Centered on the macula:
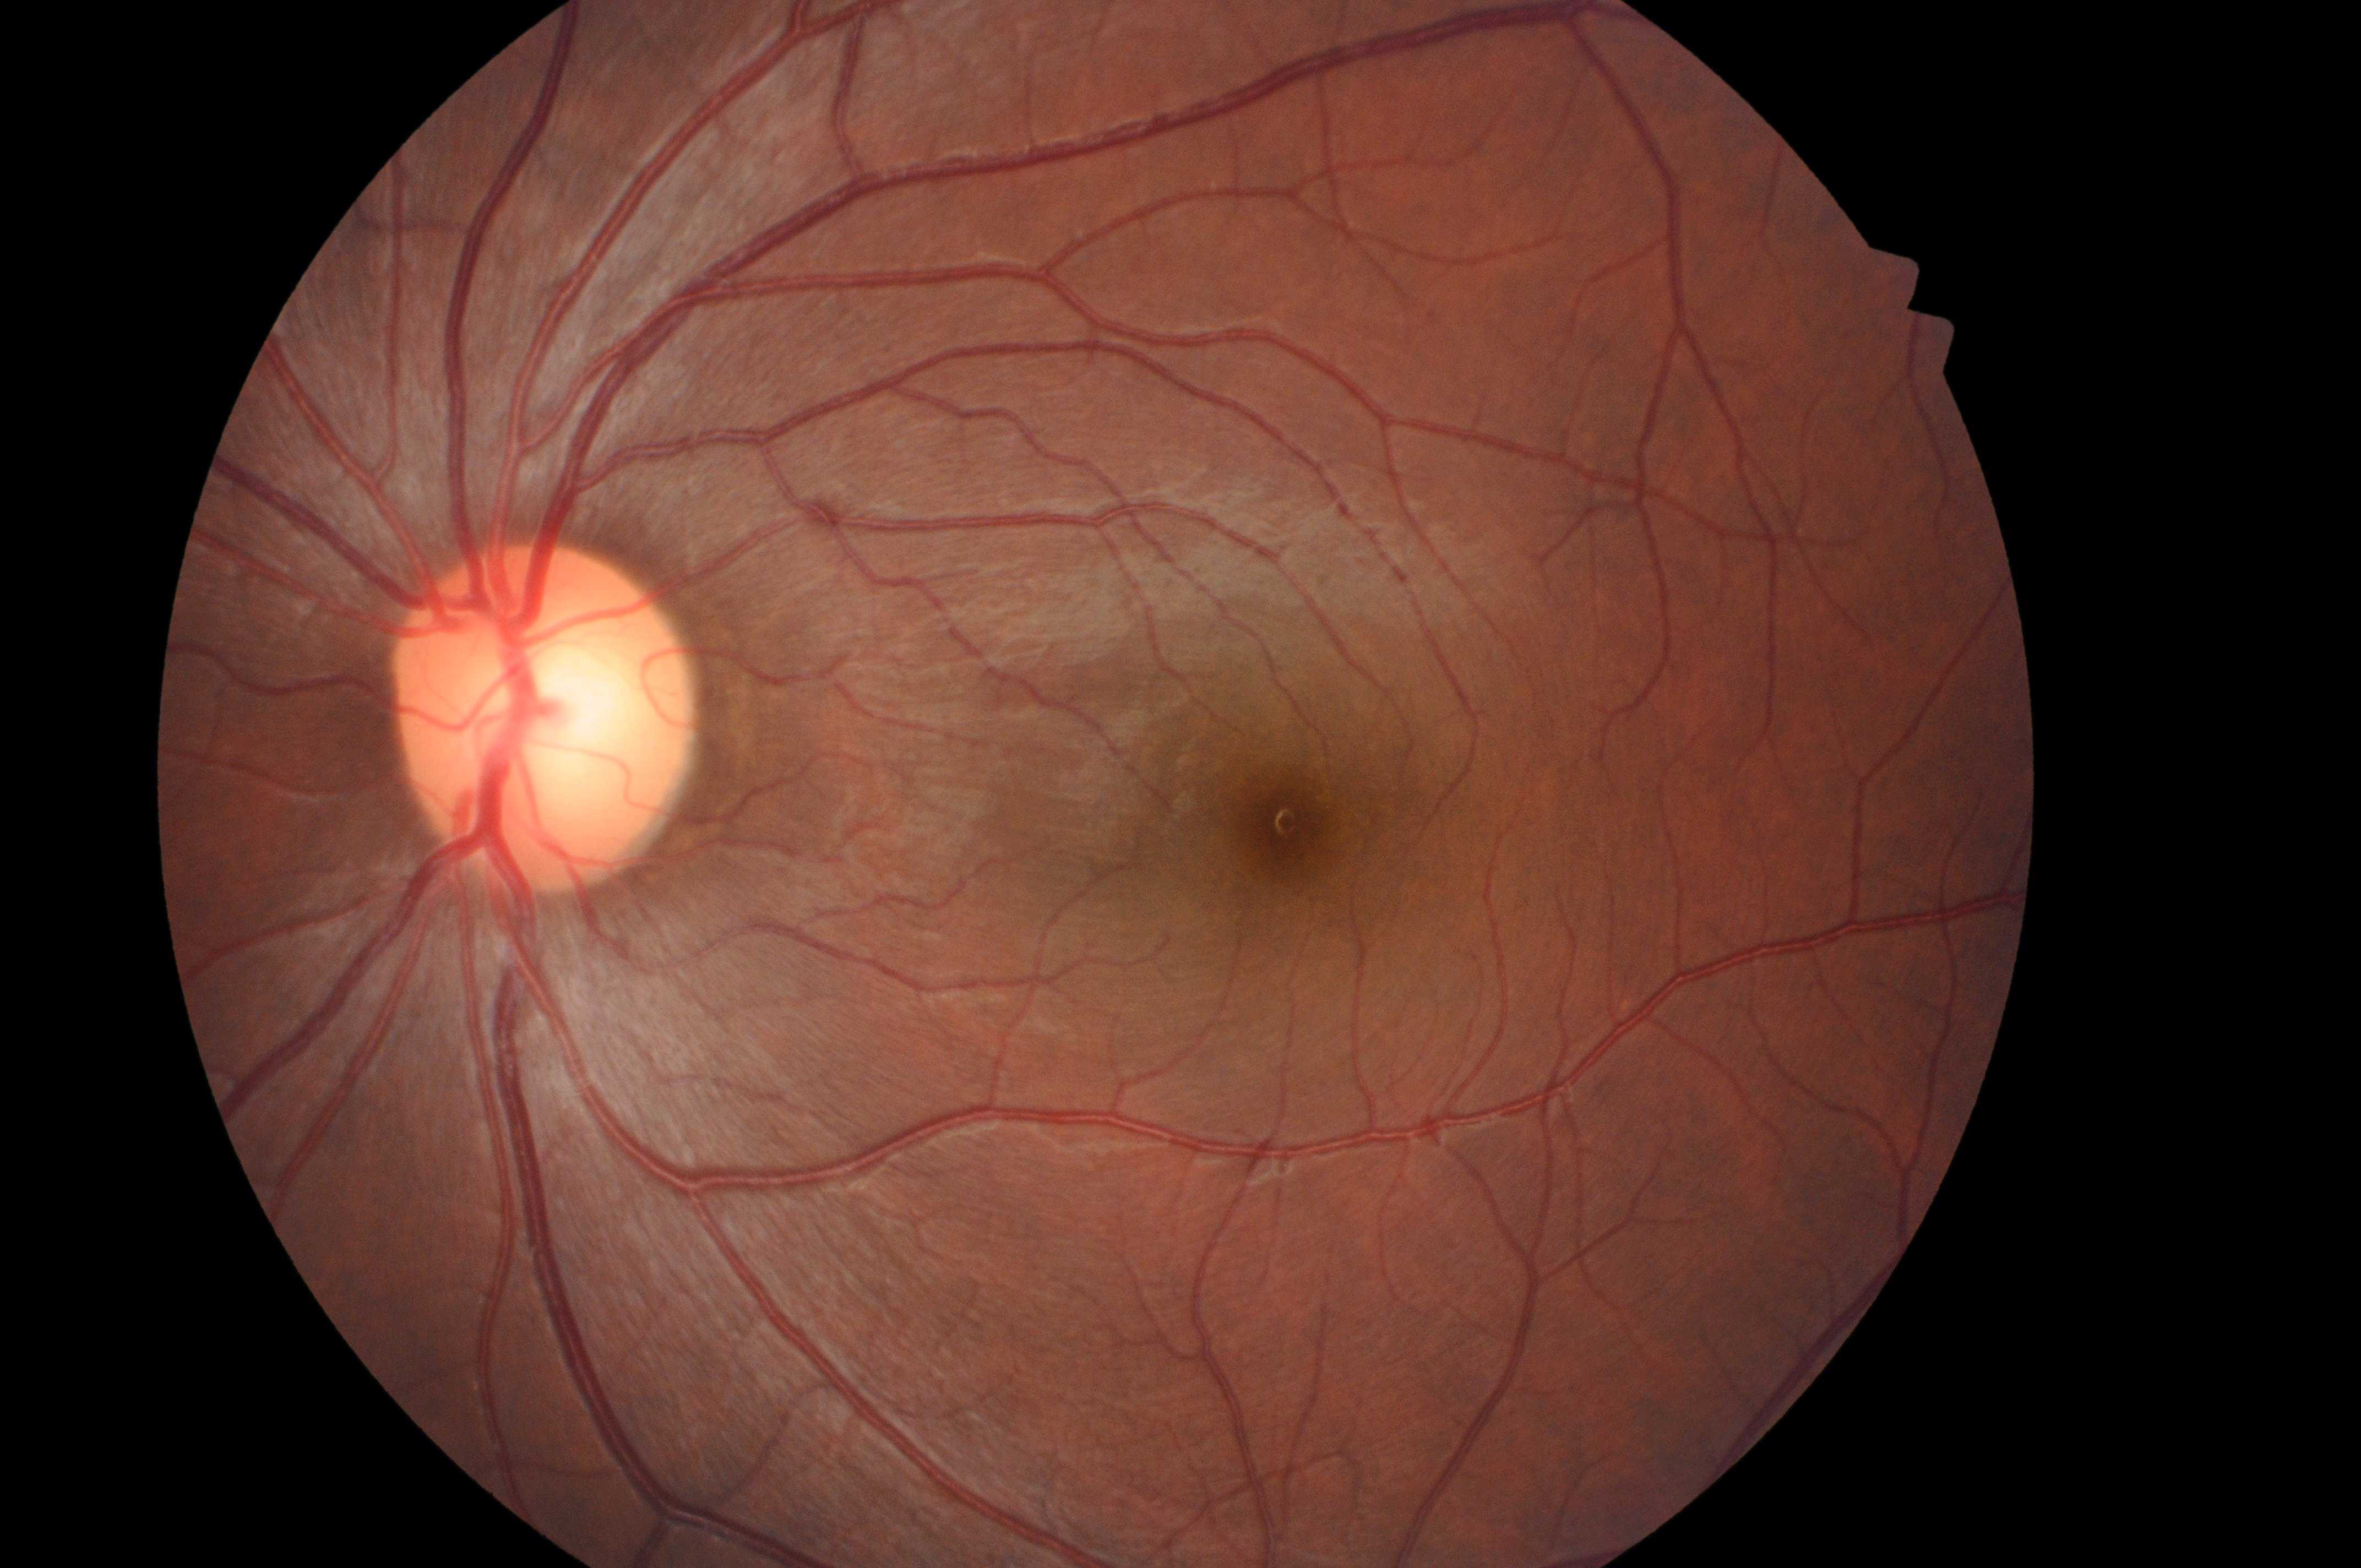
The image shows the left eye.
DR grade: 0 (no apparent retinopathy).
Optic disk located at x=540, y=726.
DME risk: no risk (grade 0).
Fovea located at x=1293, y=835.